Acquired with a Topcon TRC-NW8.
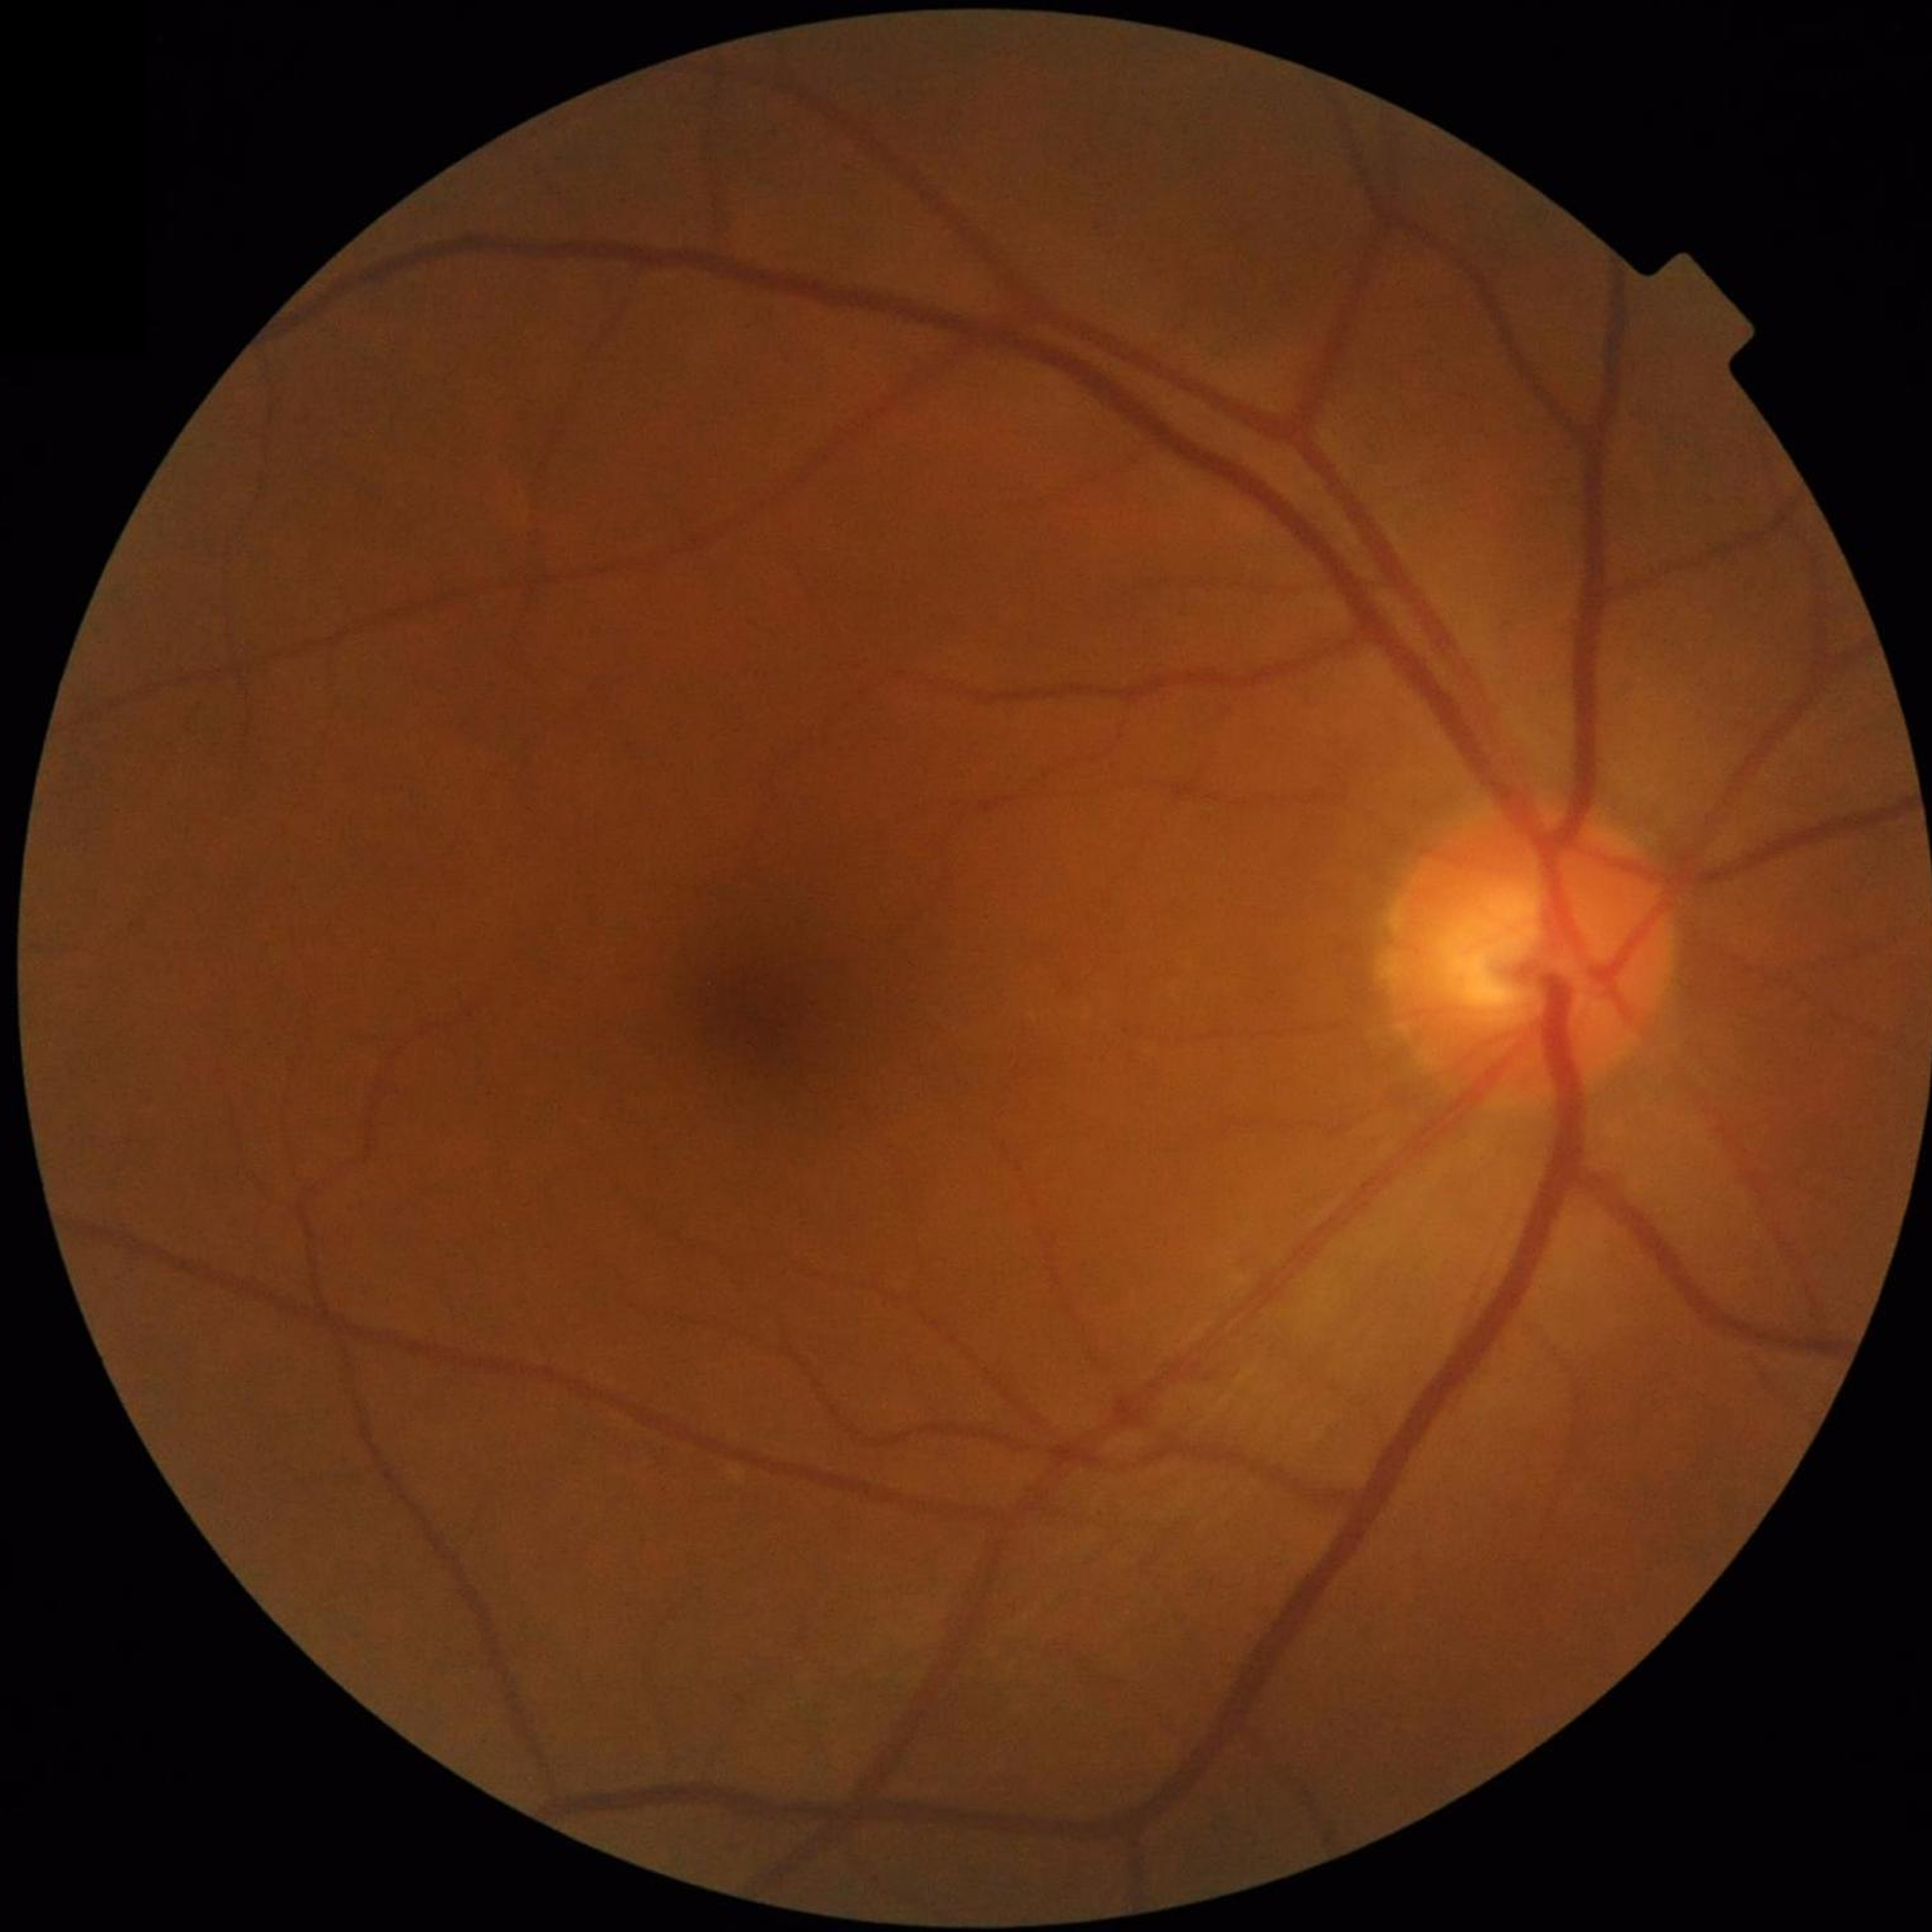
Diagnosis: no AMD, DR, or glaucoma.